No pharmacologic dilation — 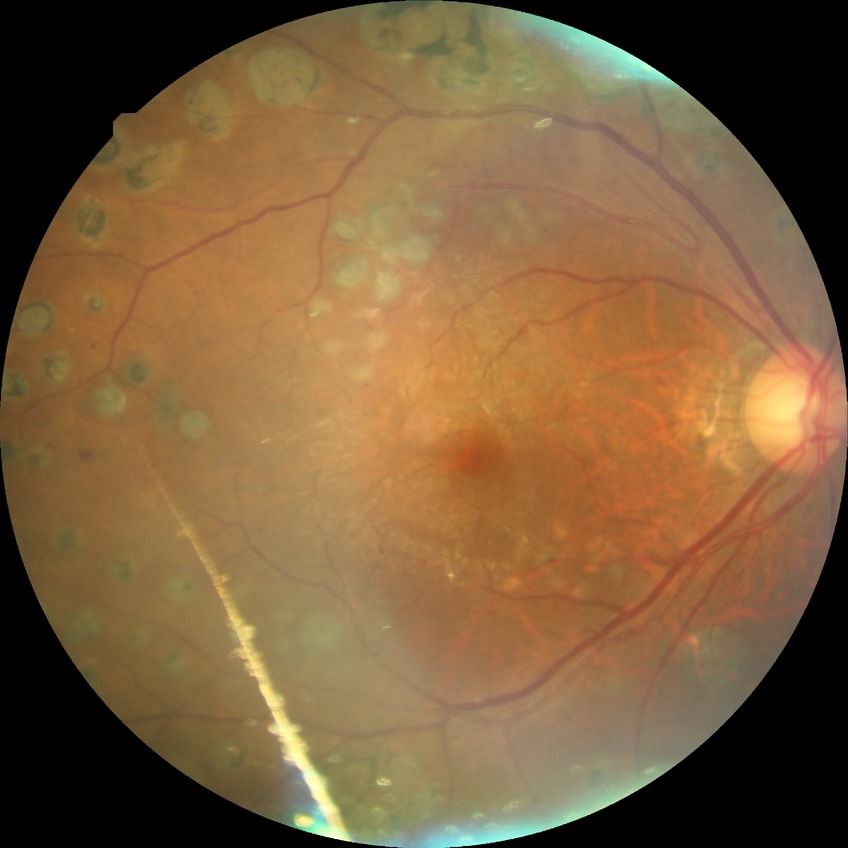
Modified Davis classification is proliferative diabetic retinopathy.